Acquired with a Topcon TRC-50DX, posterior pole view, dilated-pupil acquisition:
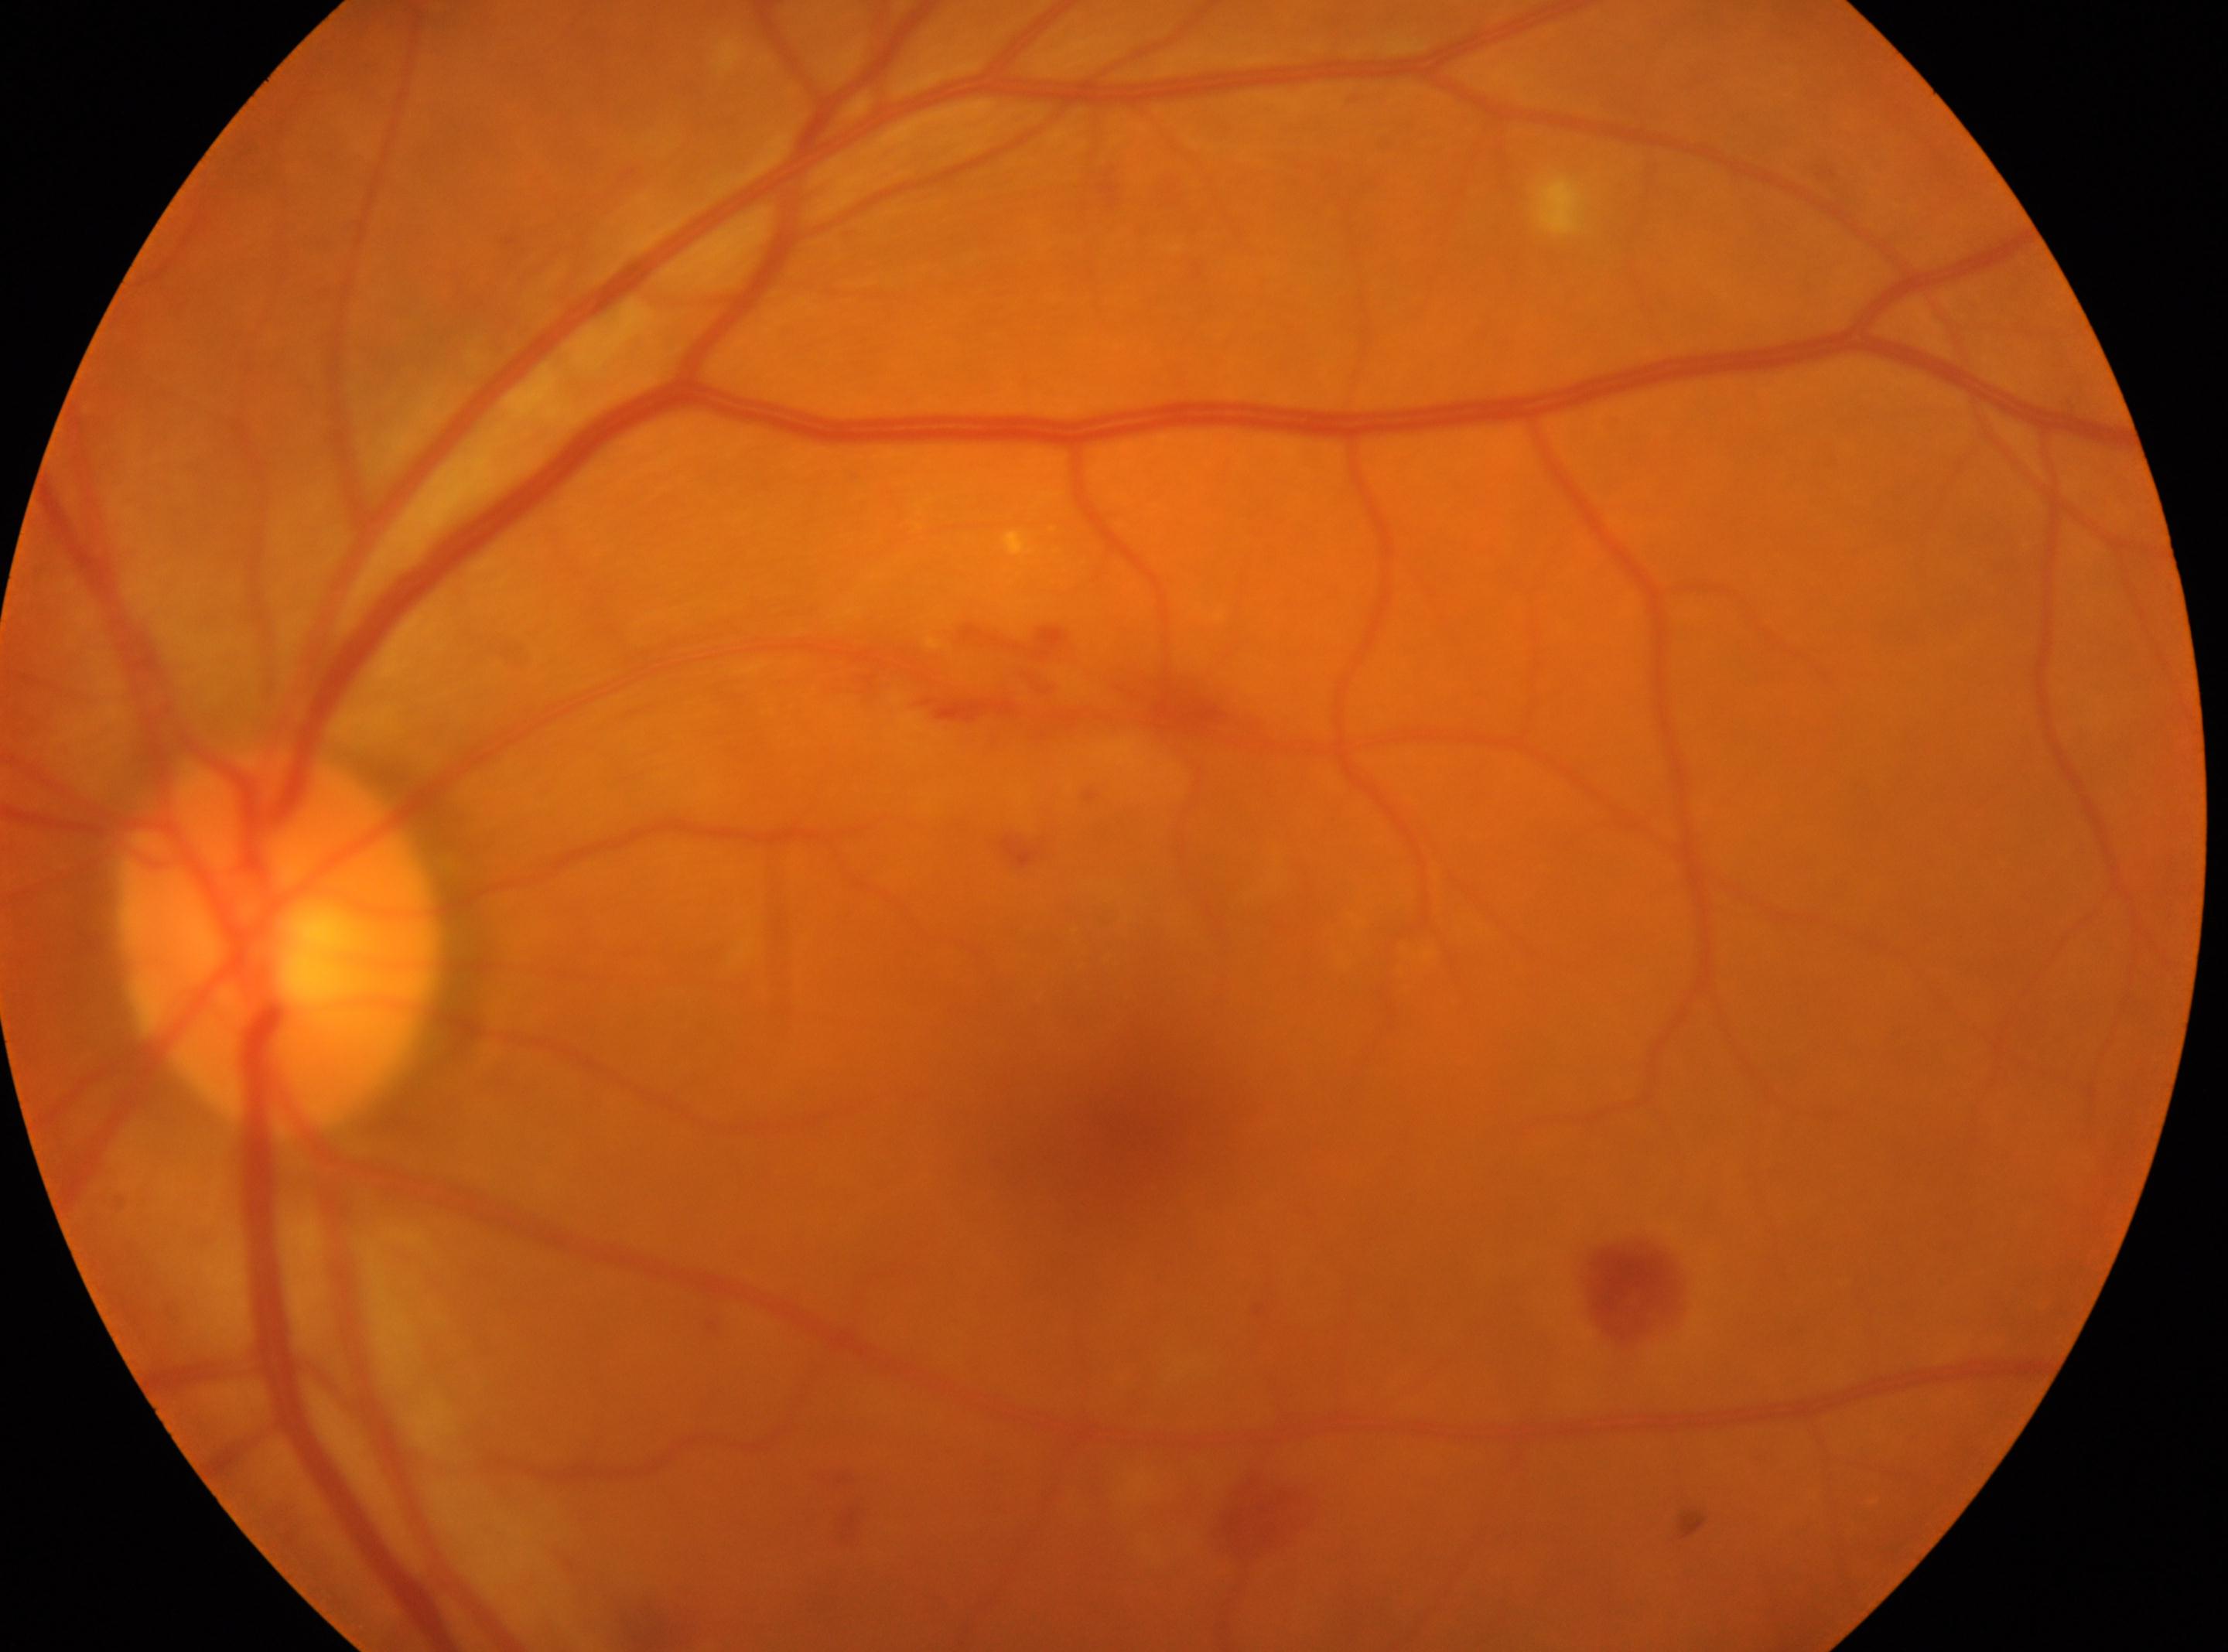 Diabetic retinopathy is 2/4. Disc center: (280,939). The foveal center is at (1117,1143). The image shows the left eye.